UWF retinal mosaic — 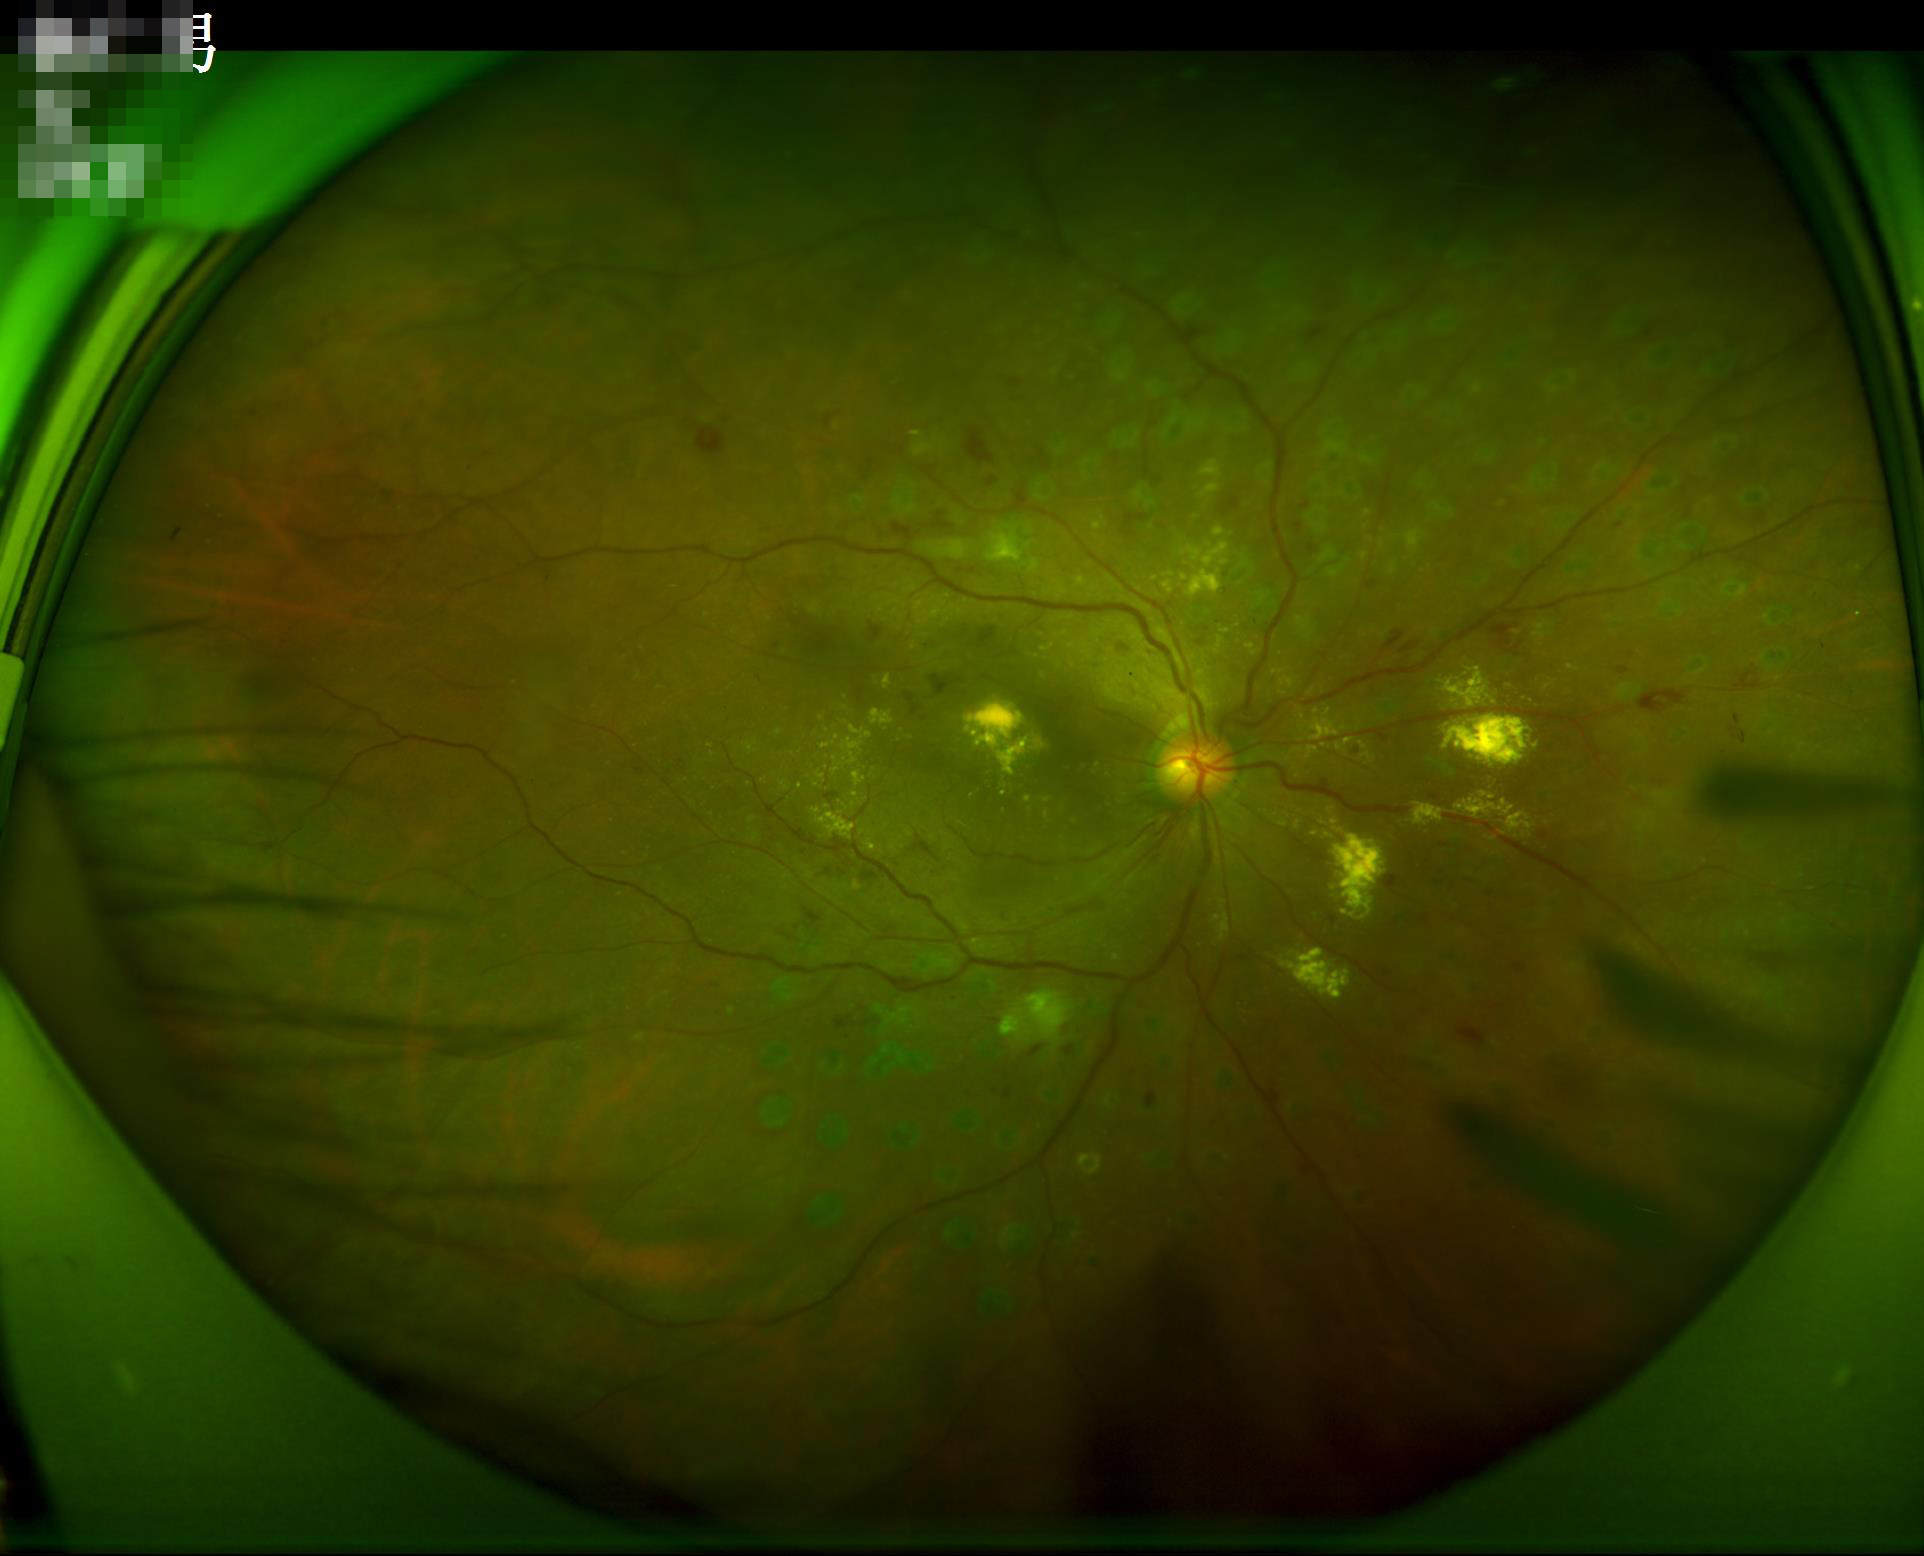
Good dynamic range.
Illumination and color balance are good.